2089 x 1764 pixels. Color fundus image
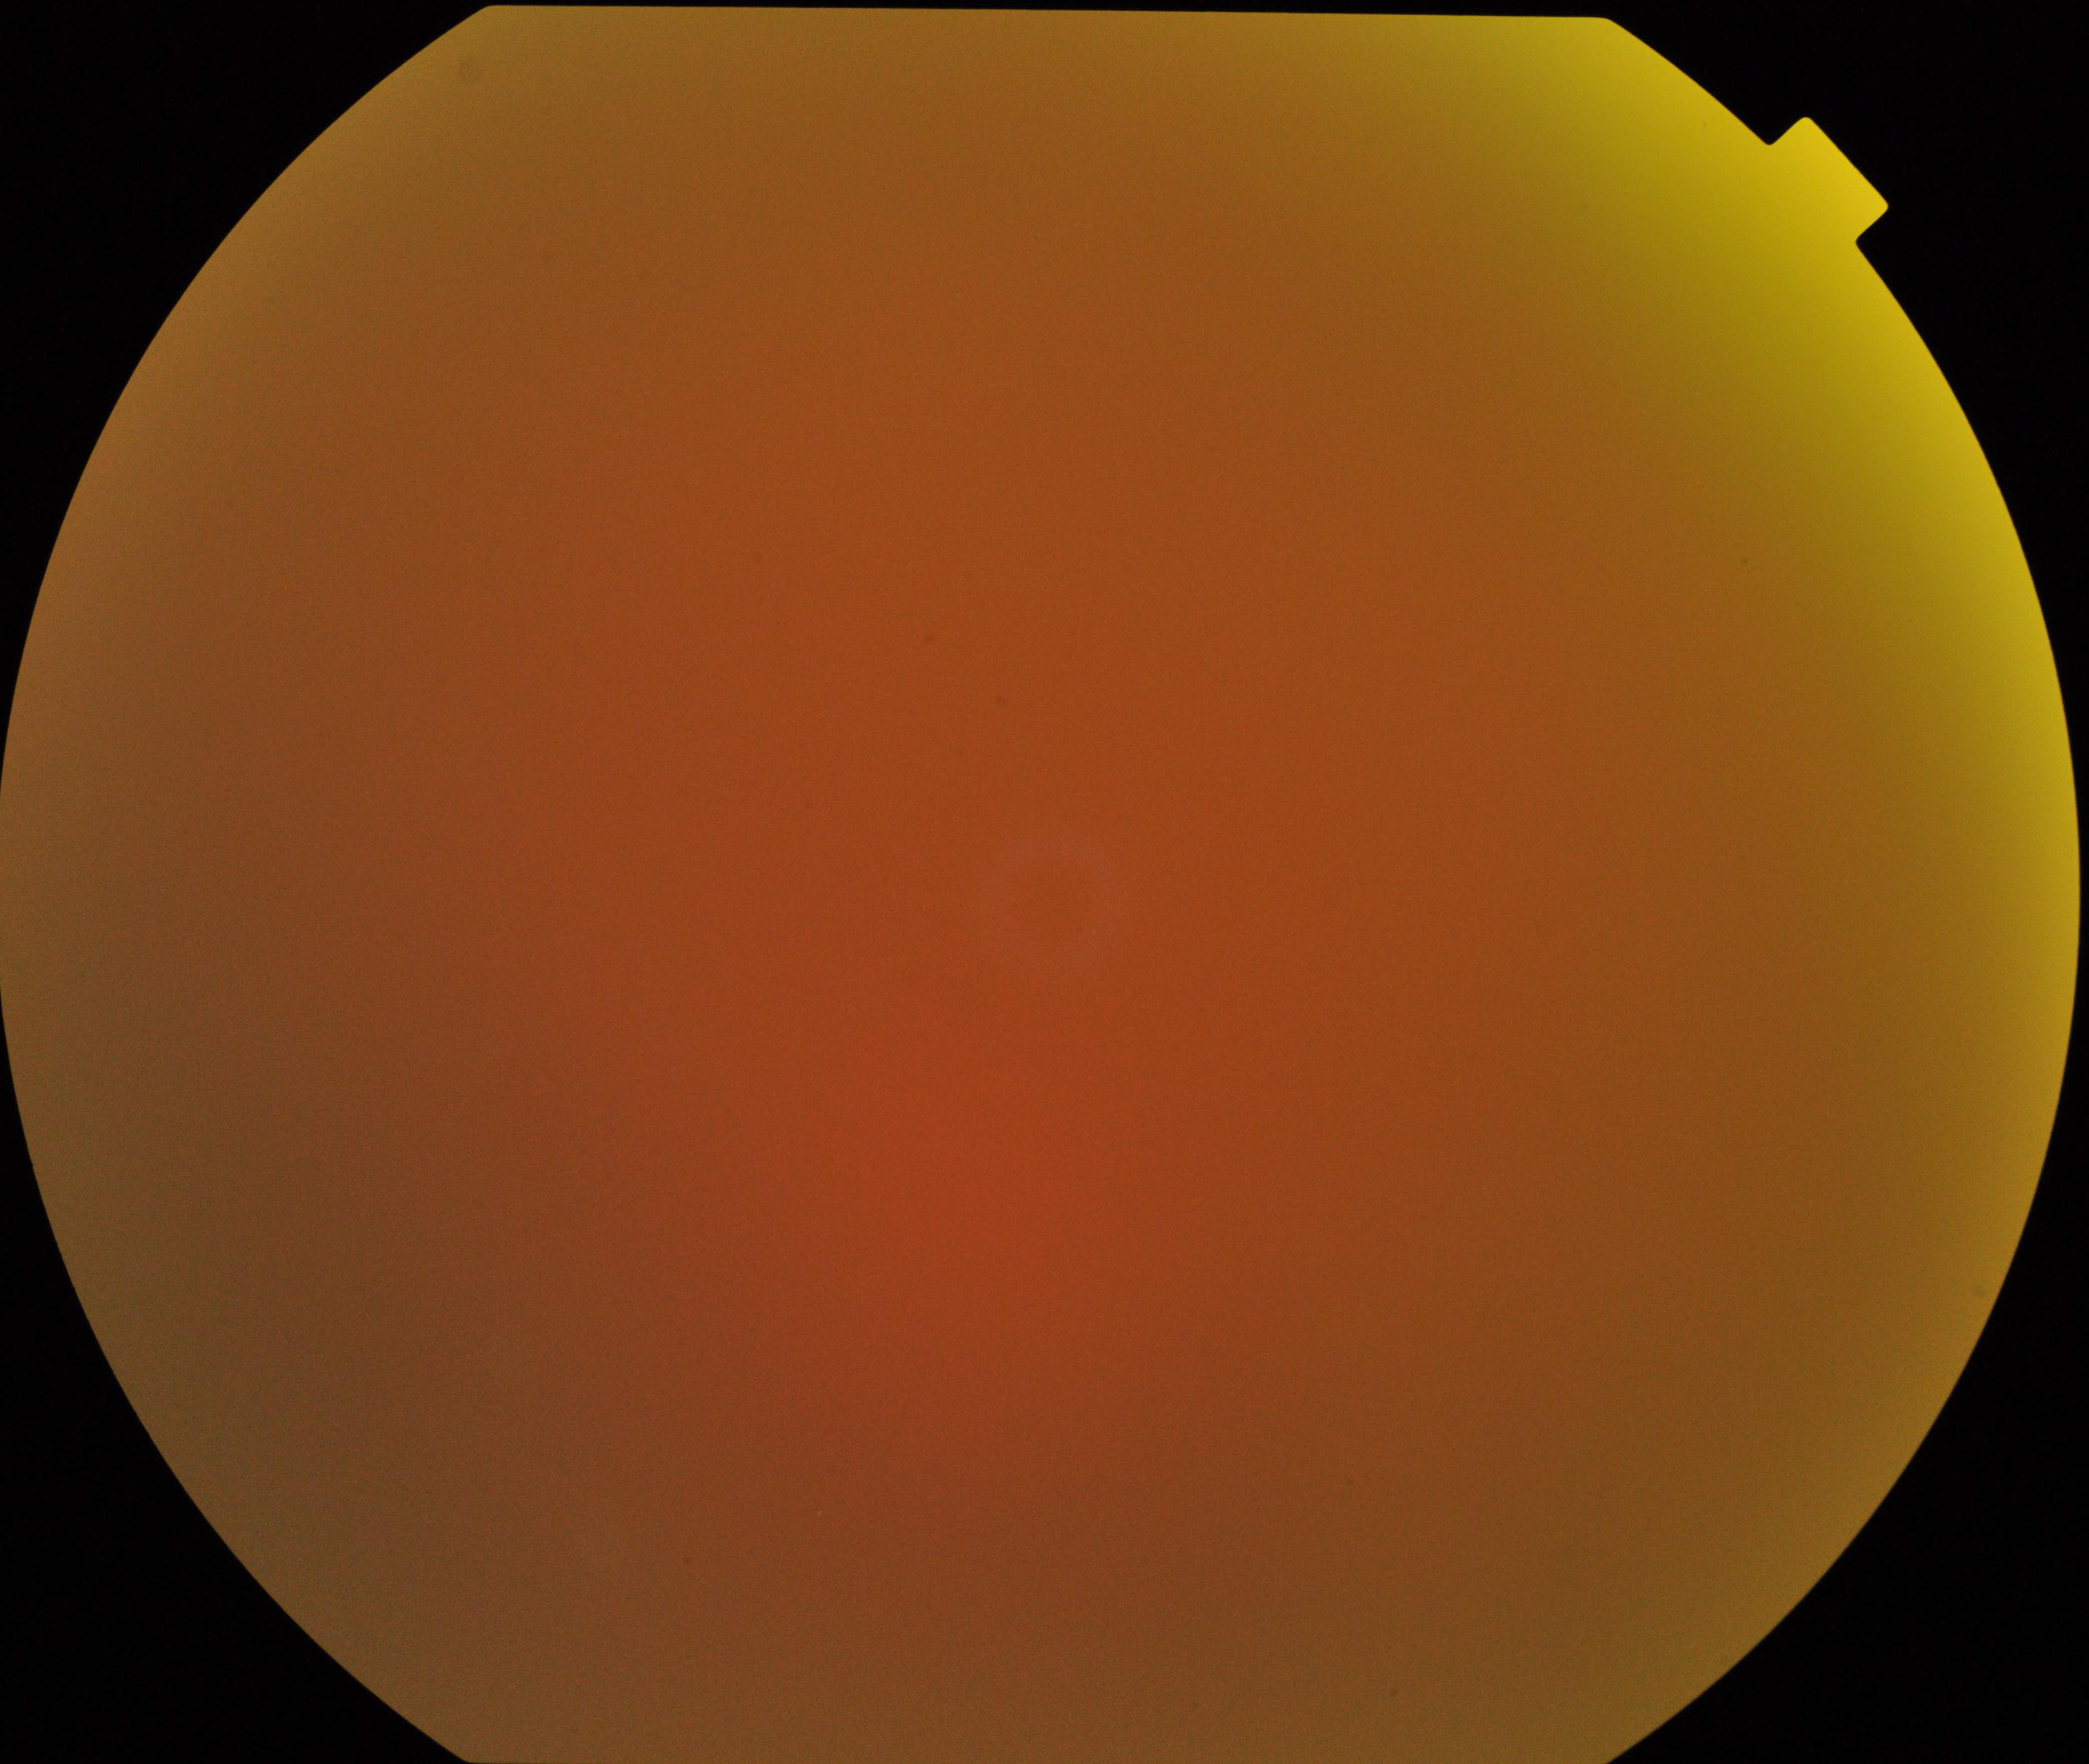

Image quality is poor; more than half the field is obscured. No evidence of proliferative diabetic retinopathy.